FOV: 45 degrees — 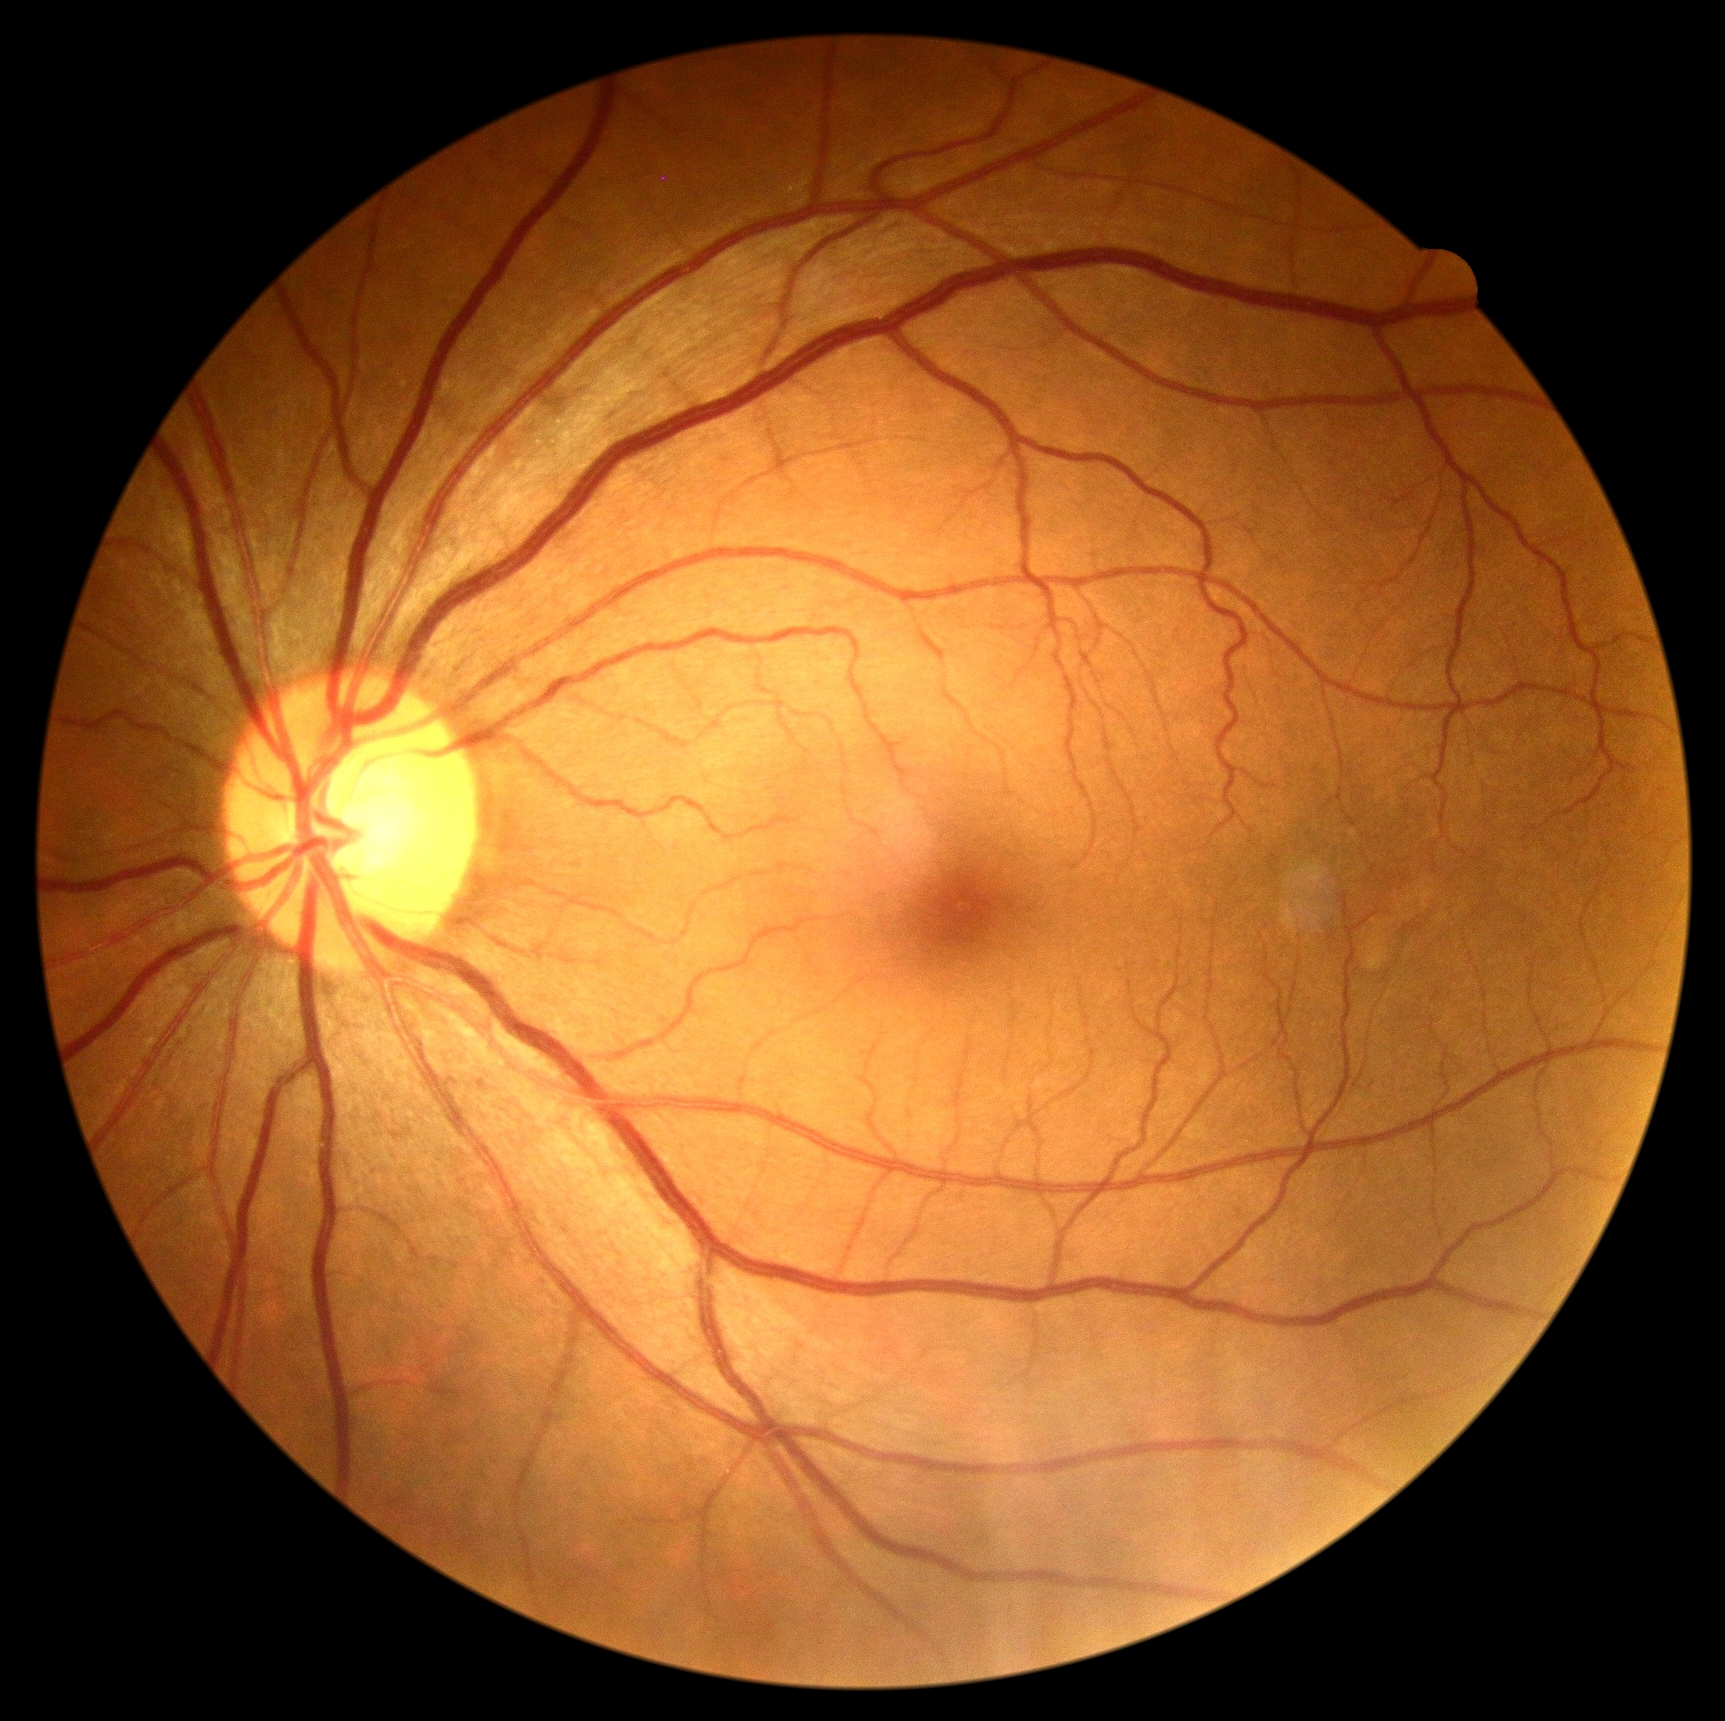 * DR stage: 0